45° FOV · modified Davis classification · image size 848x848:
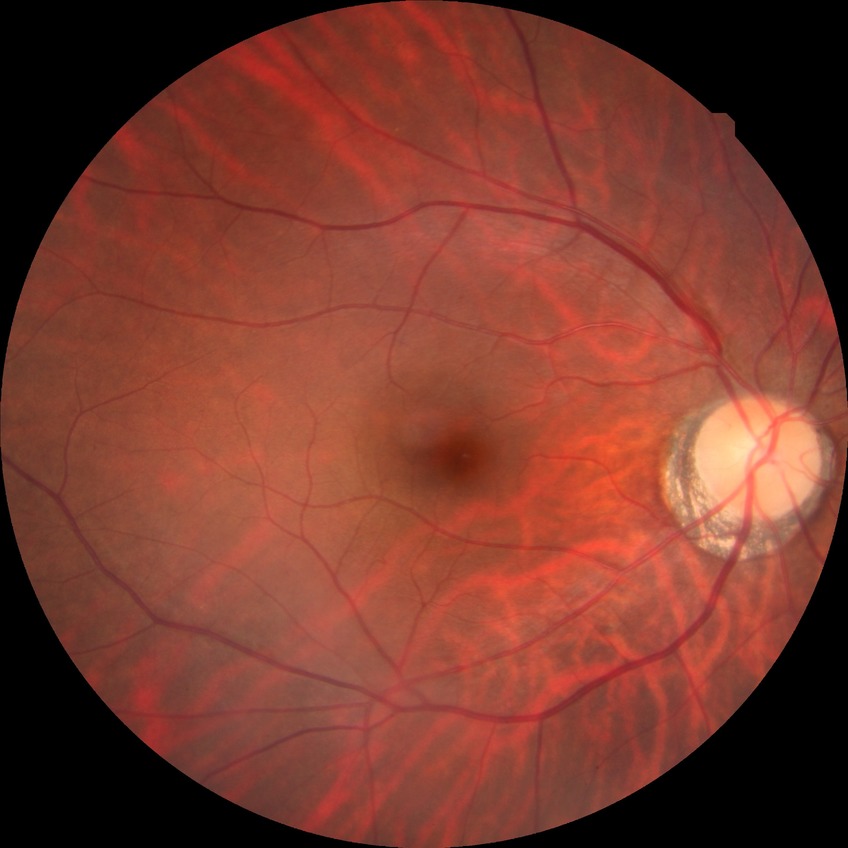
Modified Davis classification is no diabetic retinopathy.